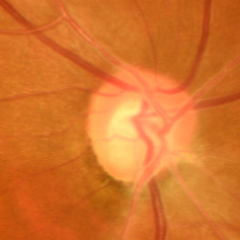 Color fundus photograph showing early glaucomatous optic neuropathy. Diagnostic criteria: glaucomatous retinal nerve fiber layer defects on red-free fundus photography without visual field defects.